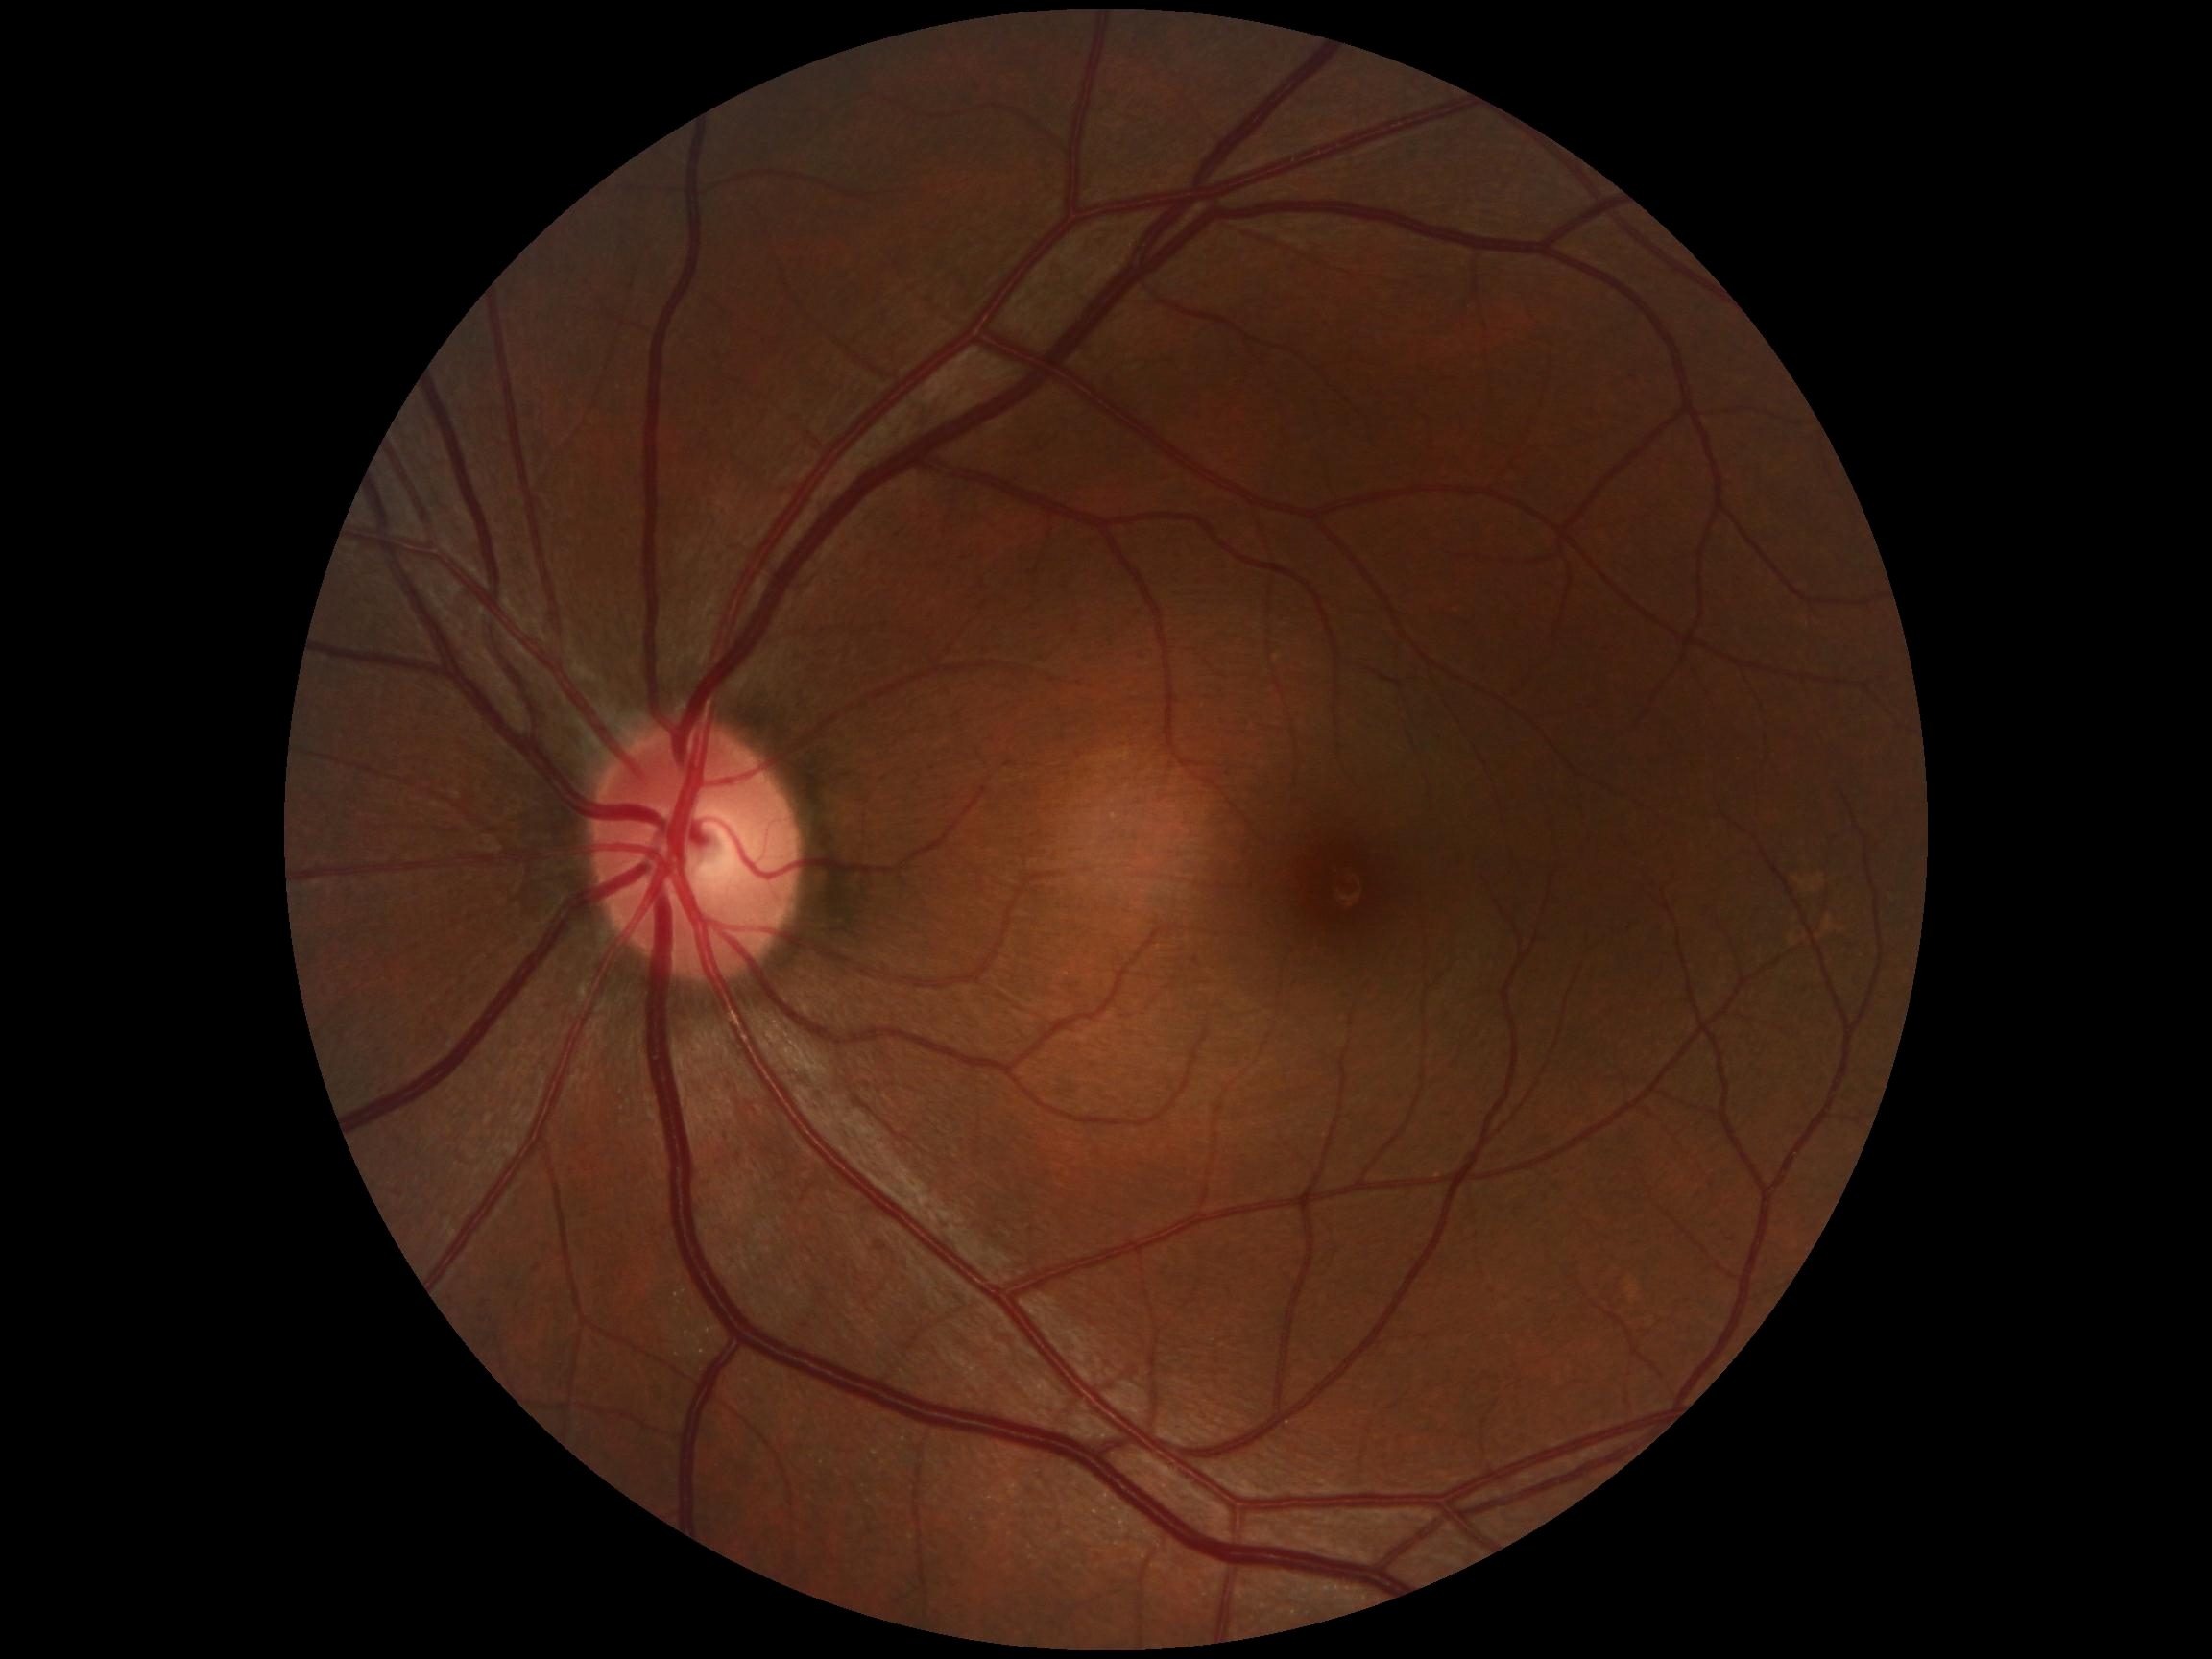

No diabetic retinal disease findings. DR stage: 0.